45-degree field of view, color fundus photograph, 1932x1910 — 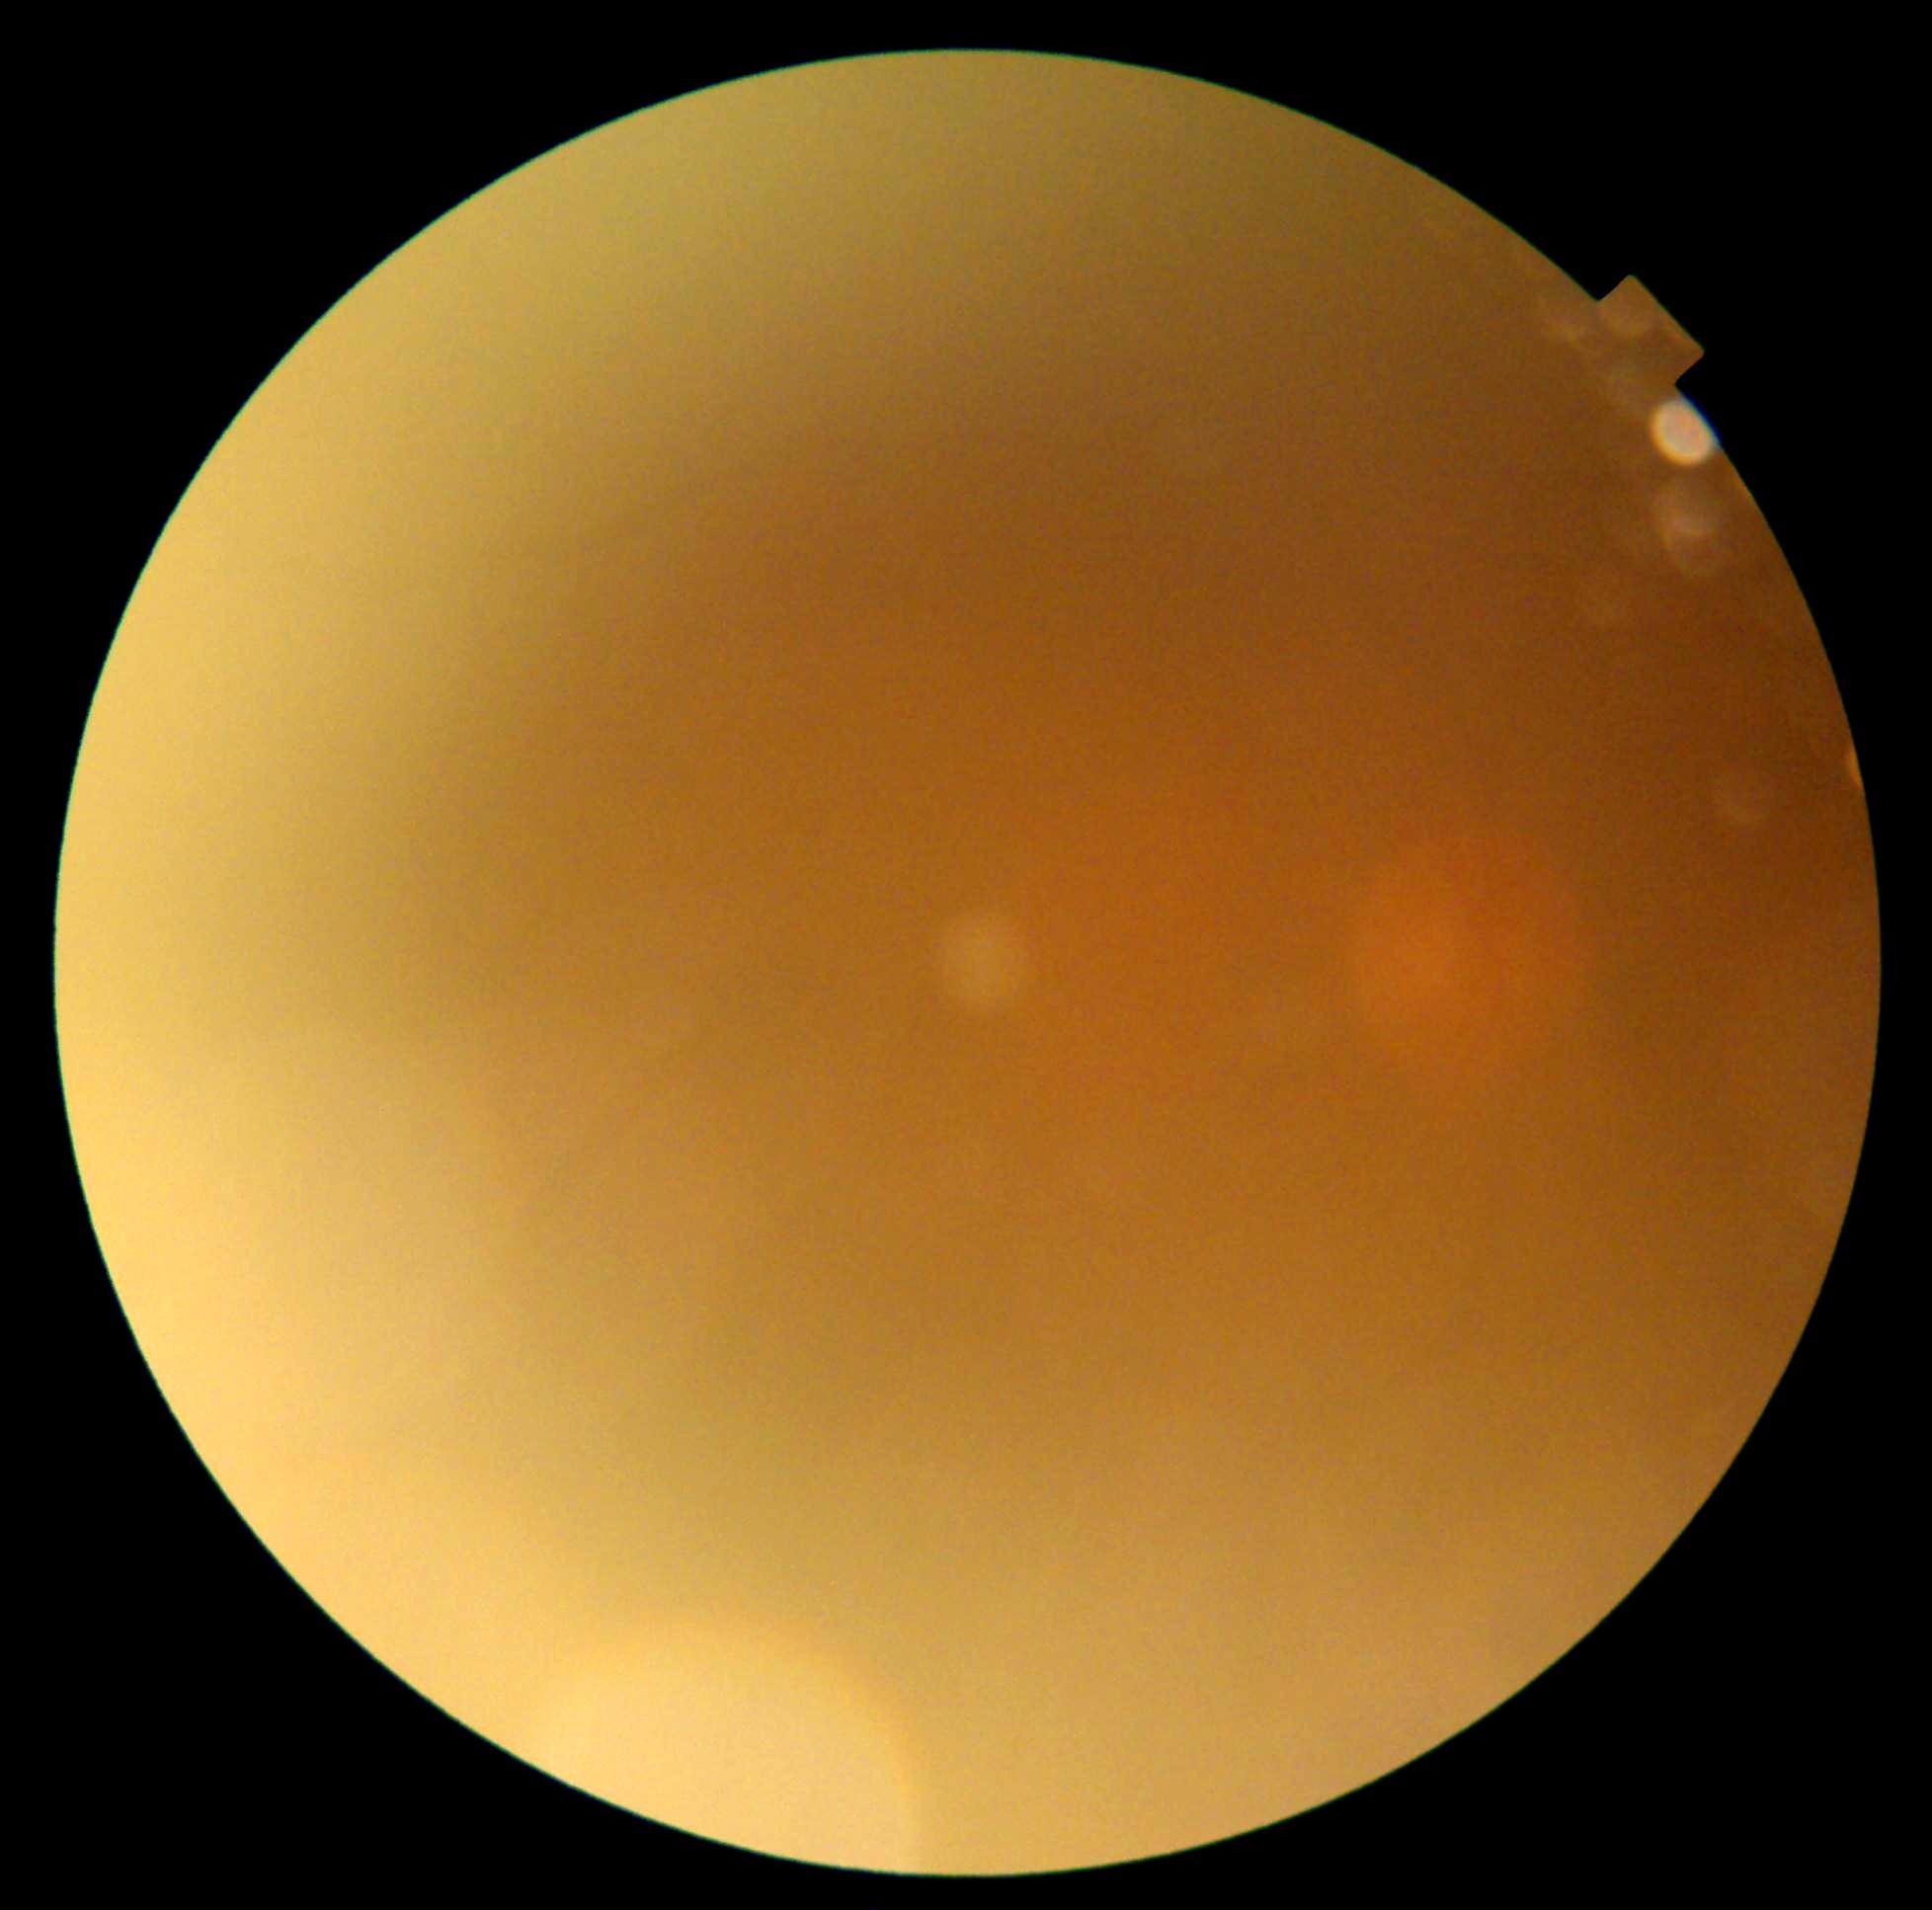
DR severity = ungradable due to poor image quality